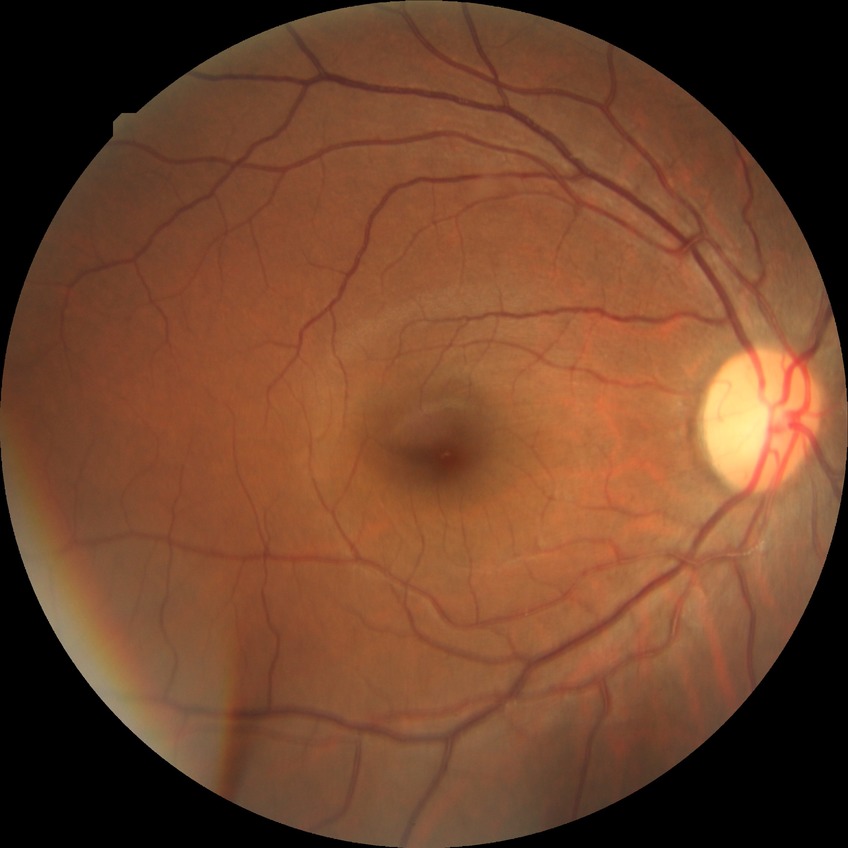

DR grade is NDR.